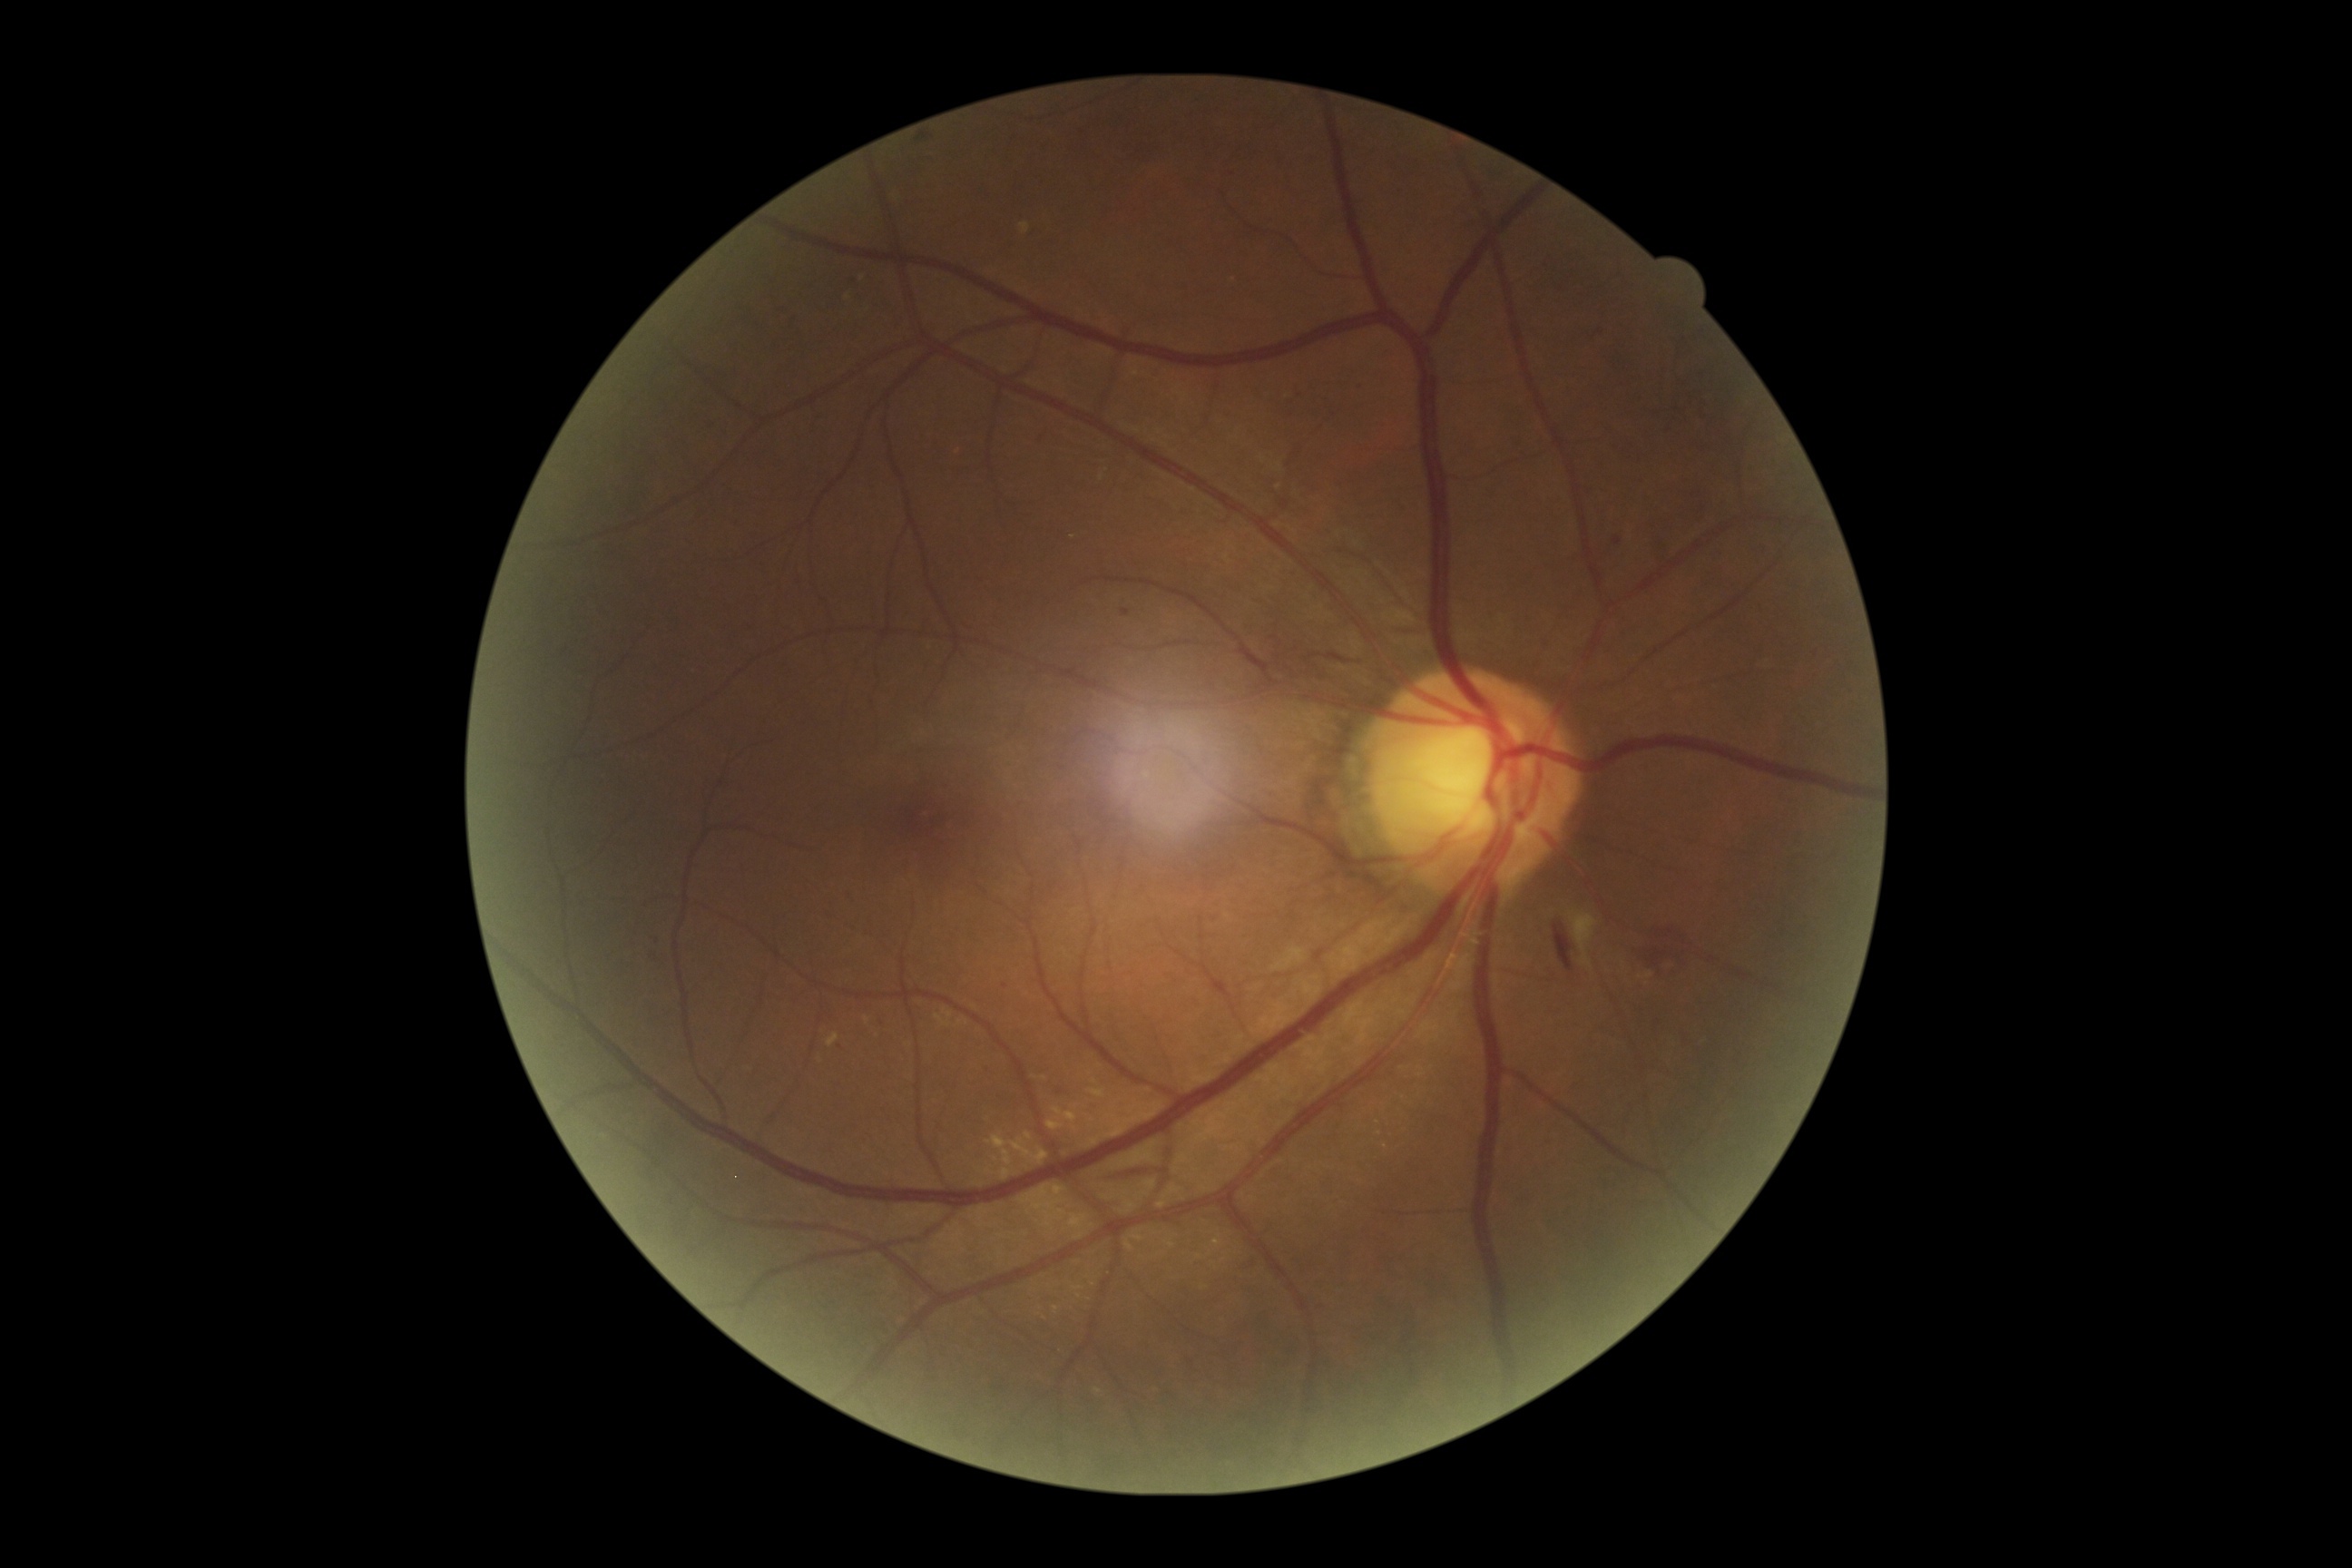

Retinopathy: grade 2 (moderate NPDR).